DR severity per modified Davis staging
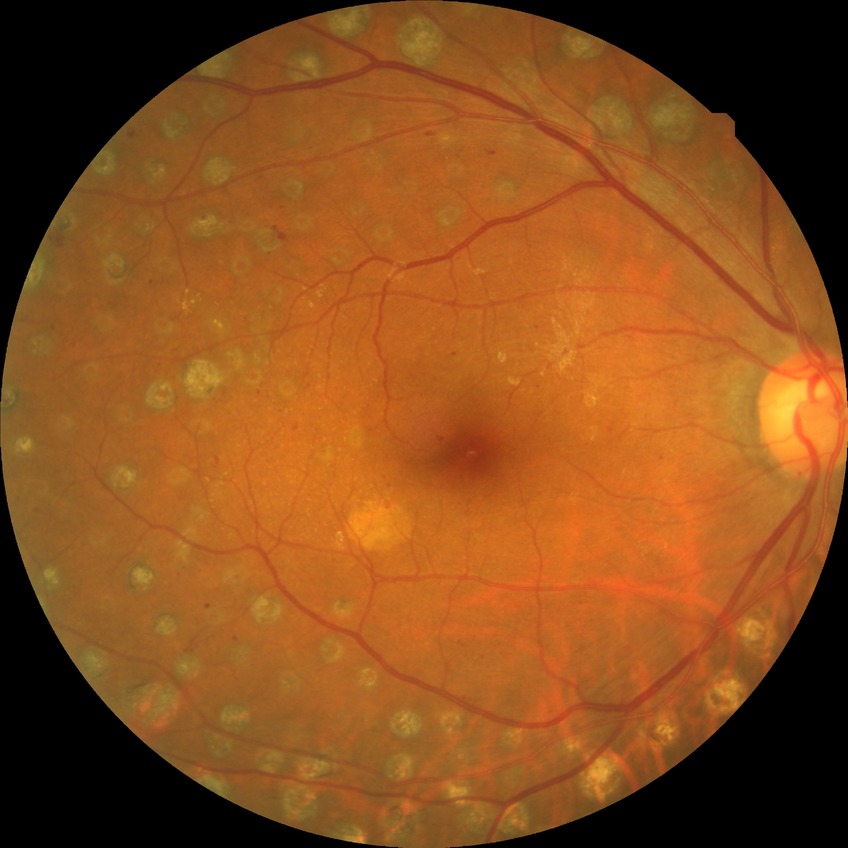 {"davis_grade": "proliferative diabetic retinopathy (PDR)"}